NIDEK AFC-230 fundus camera, posterior pole photograph, DR severity per modified Davis staging — 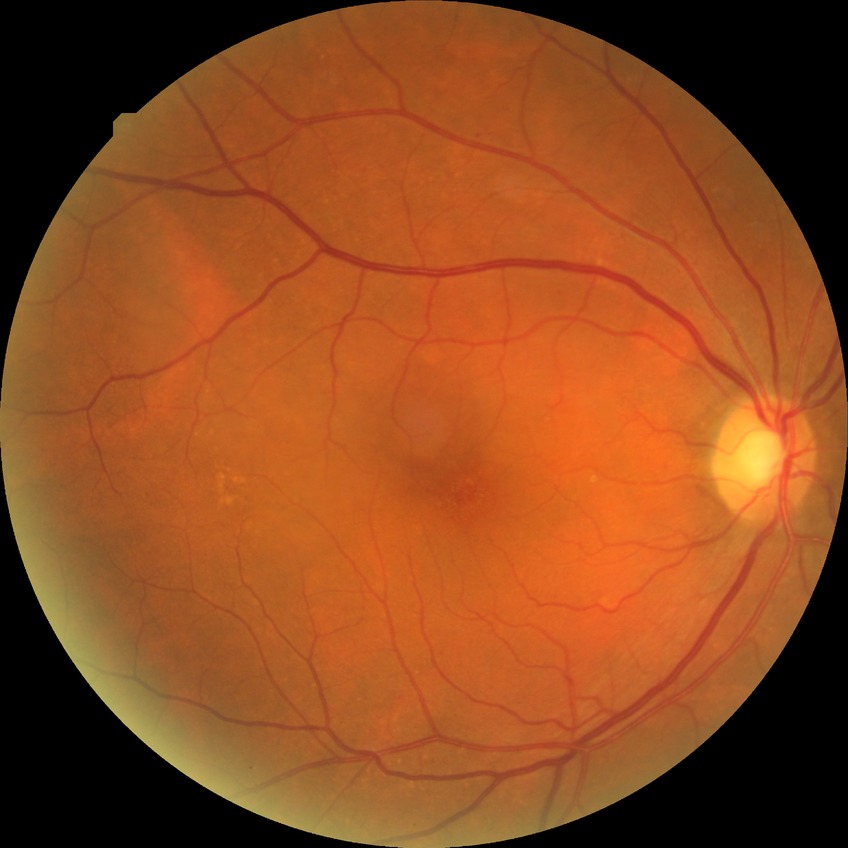 diabetic retinopathy (DR) = SDR (simple diabetic retinopathy)